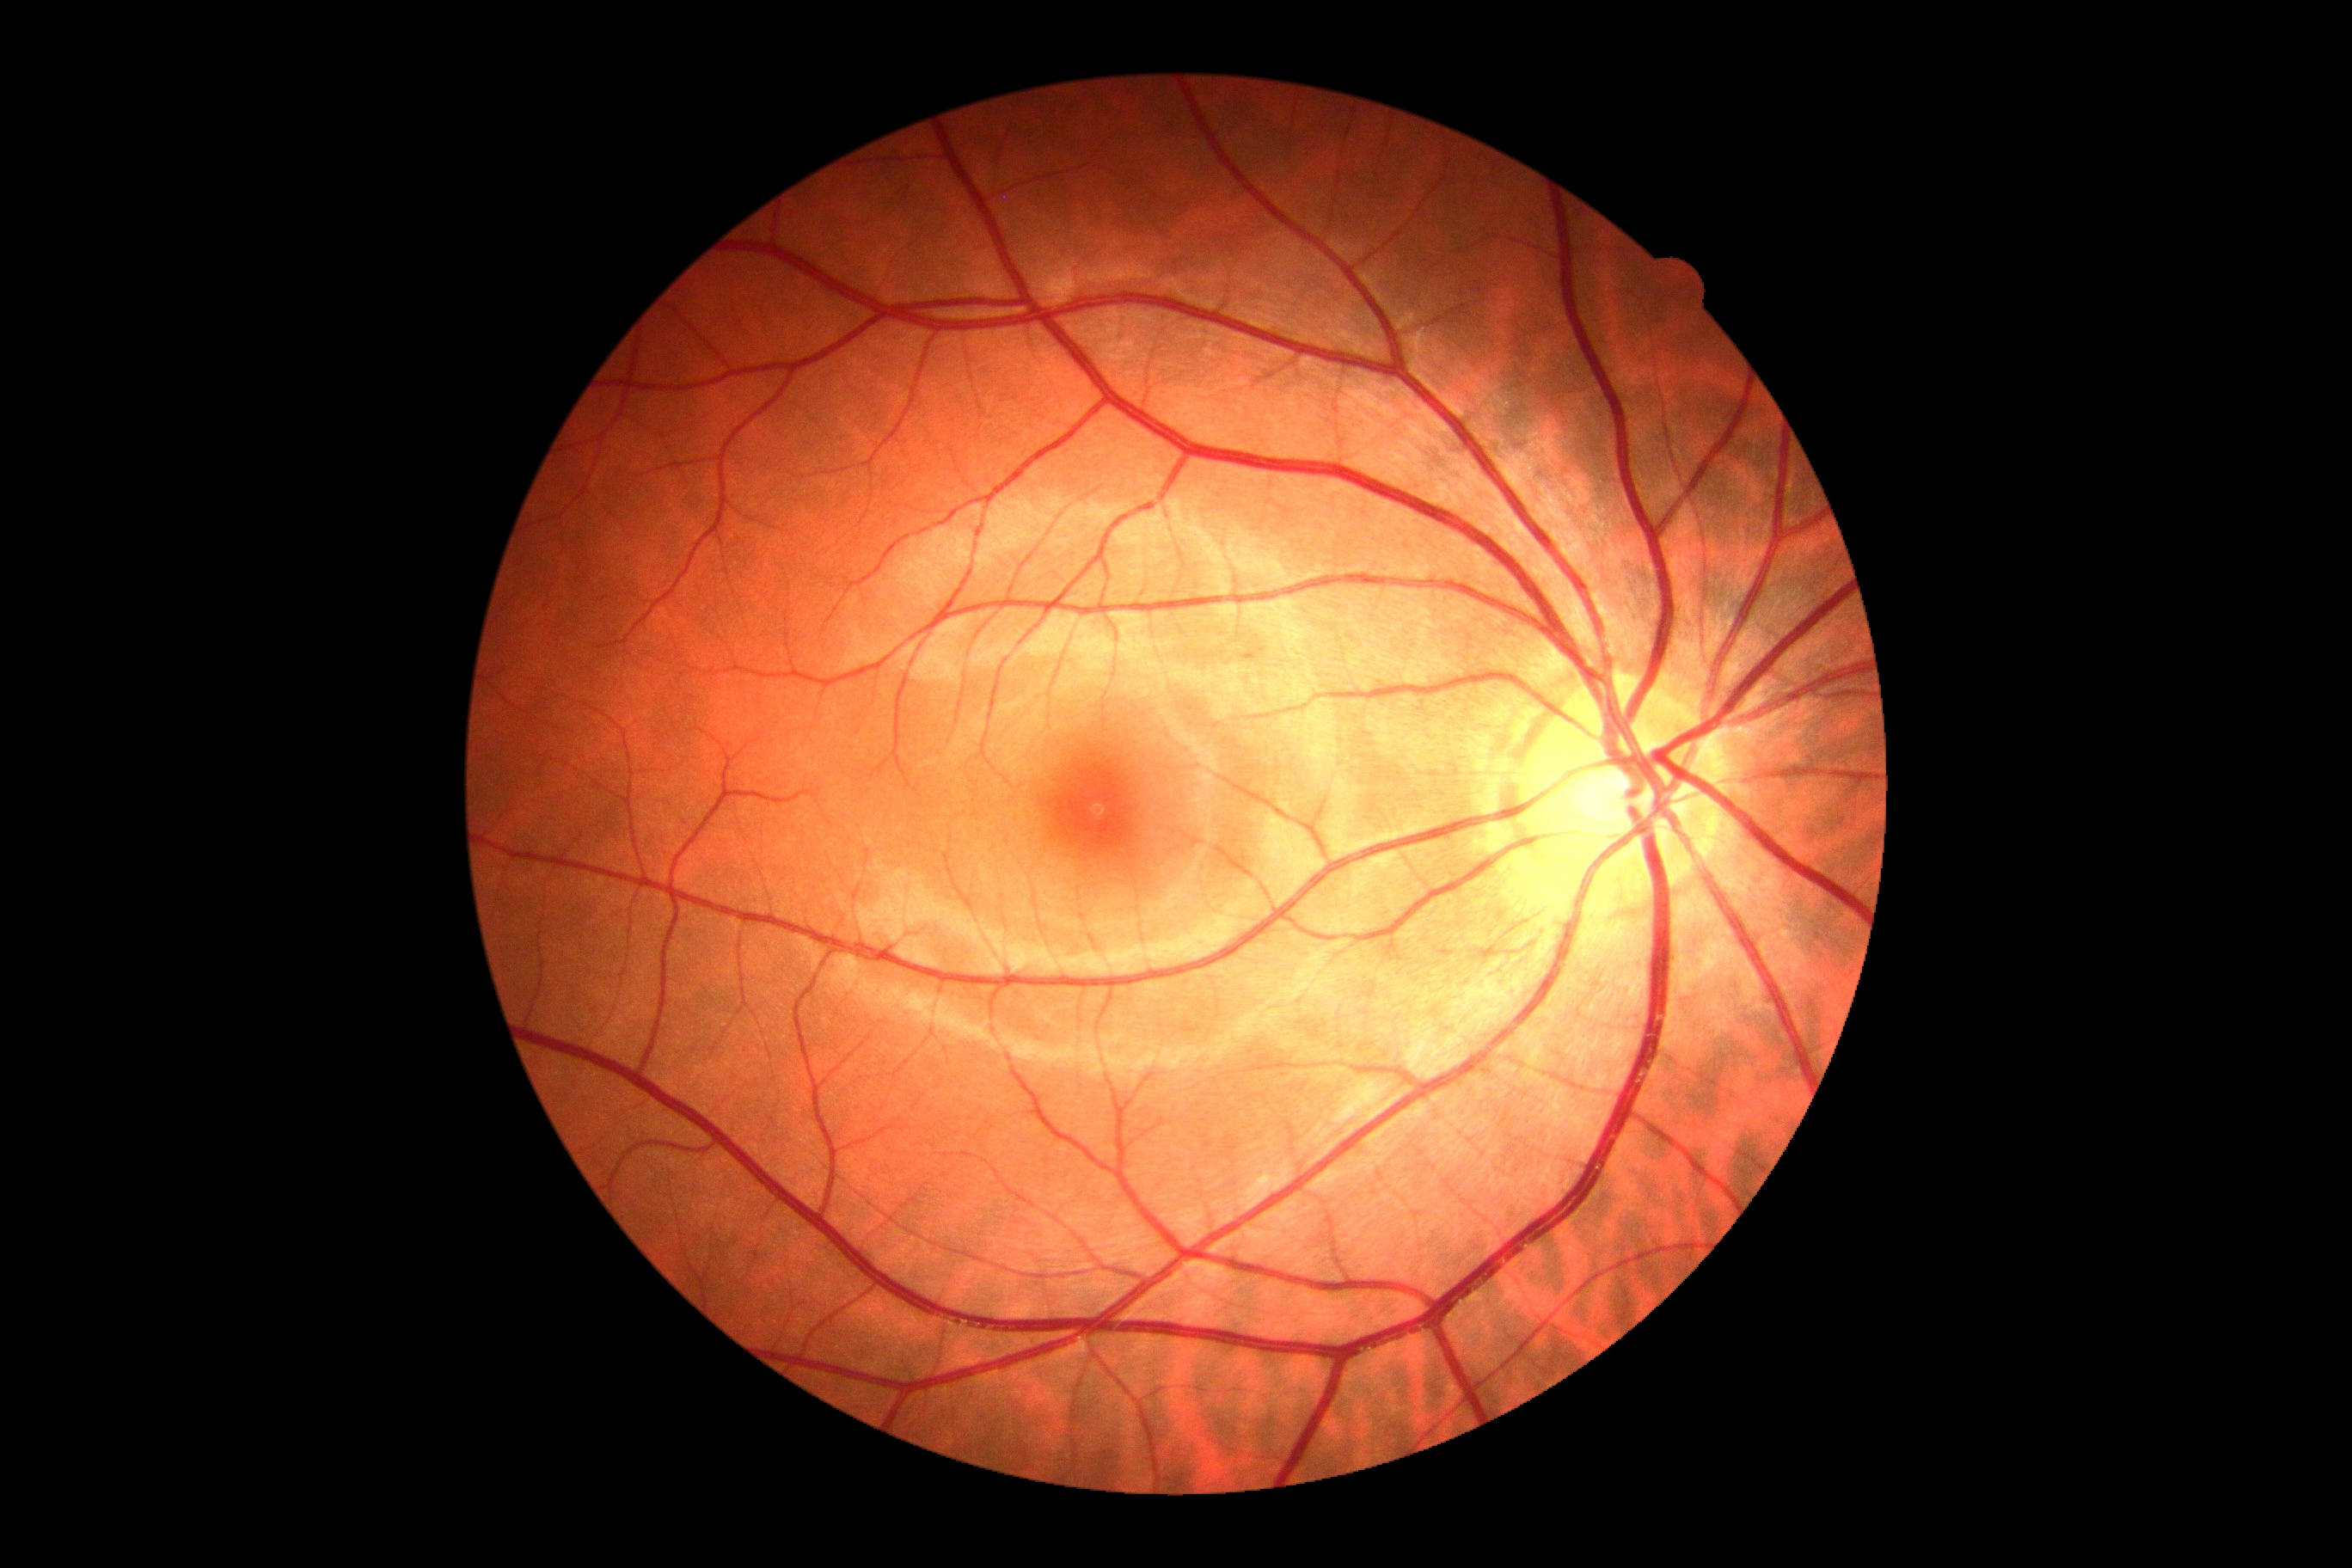 DR stage: no apparent retinopathy (grade 0).